2352x1568:
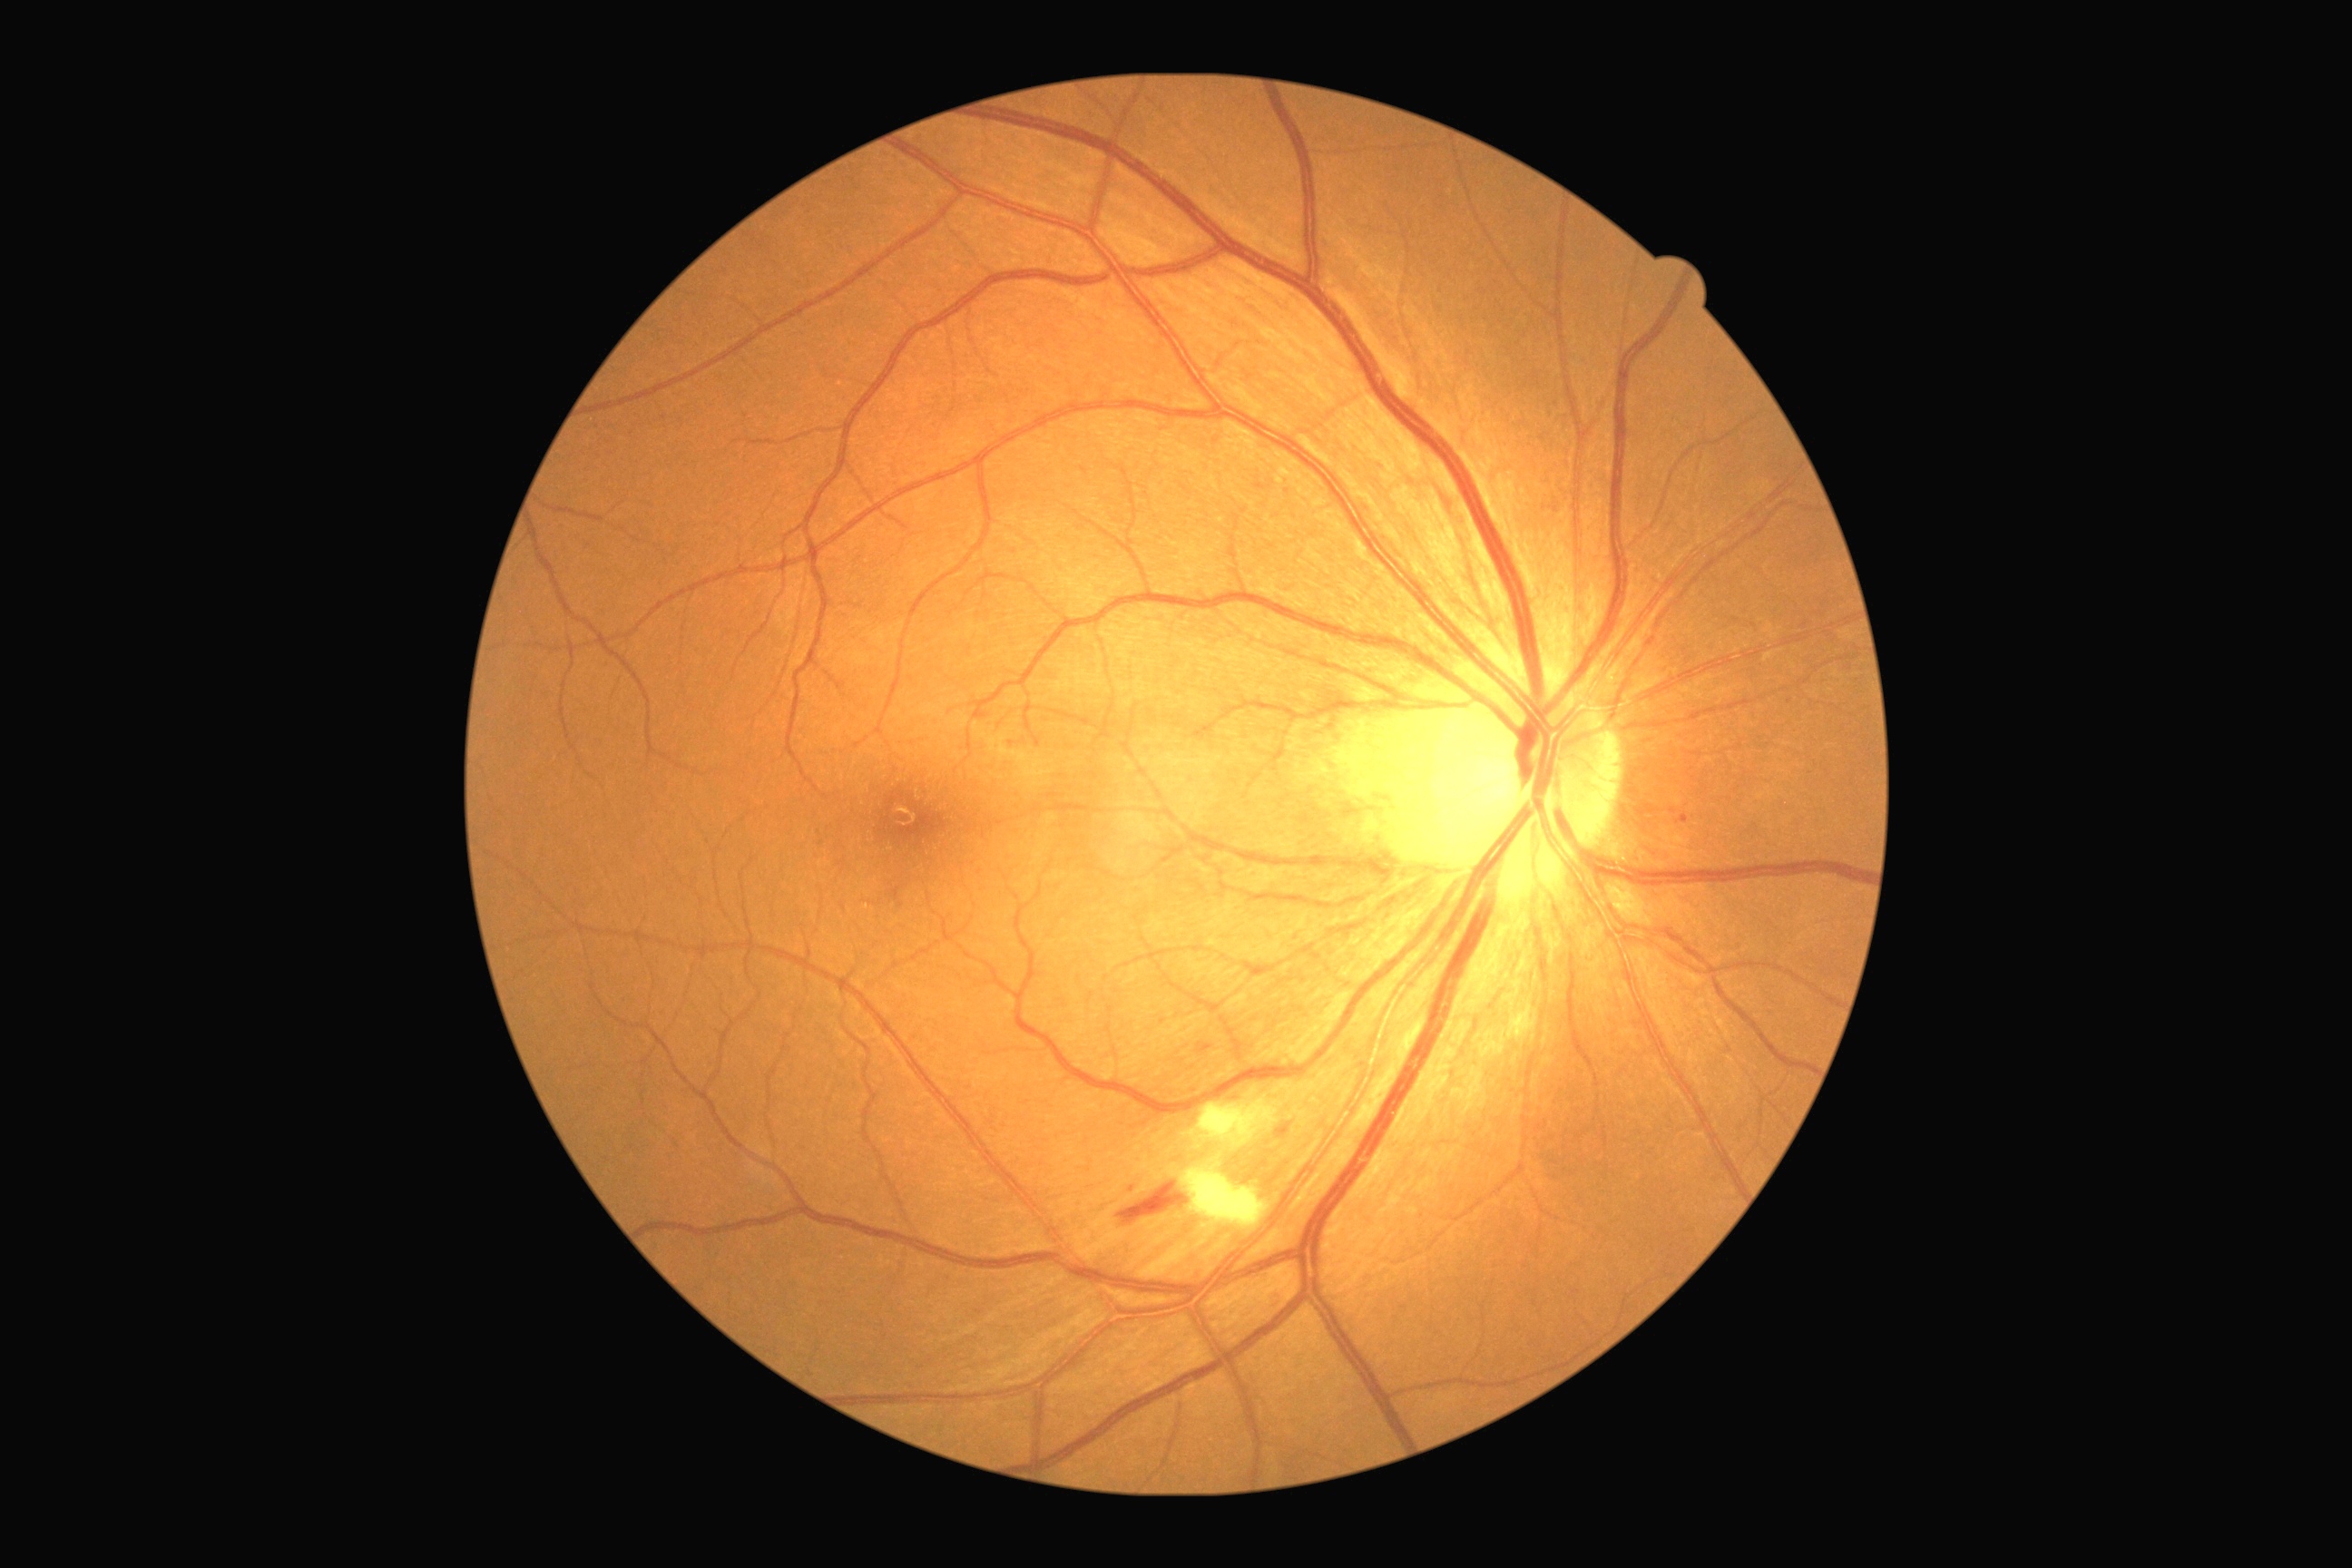 Diabetic retinopathy (DR) is moderate non-proliferative diabetic retinopathy (grade 2)
- hemorrhages (HEs): (left=1275, top=1124, right=1293, bottom=1139) | (left=1117, top=1181, right=1190, bottom=1226)
- hard exudates (EXs): absent
- soft exudates (SEs): (left=1199, top=1097, right=1284, bottom=1148) | (left=1182, top=1164, right=1271, bottom=1230)
- microaneurysms (MAs): (left=1678, top=816, right=1689, bottom=825) | (left=1197, top=1043, right=1213, bottom=1054)
- Small MAs approximately at point(1012, 744) | point(1790, 702) | point(1131, 1189)